NIDEK AFC-230; 45-degree field of view
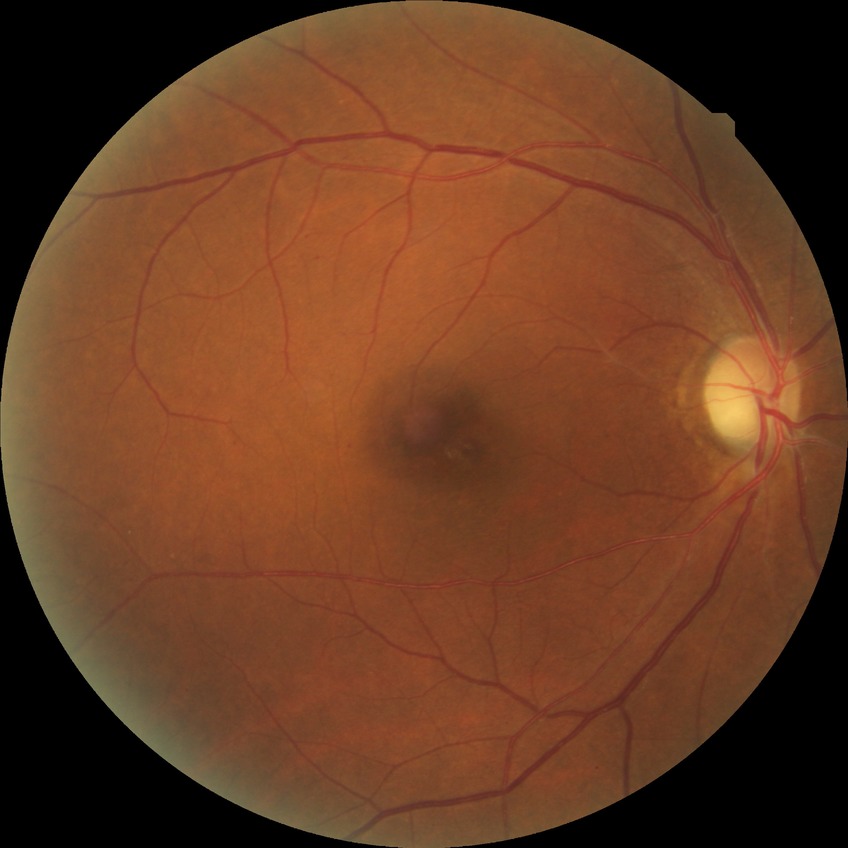 Modified Davis grade: NDR. No signs of diabetic retinopathy.